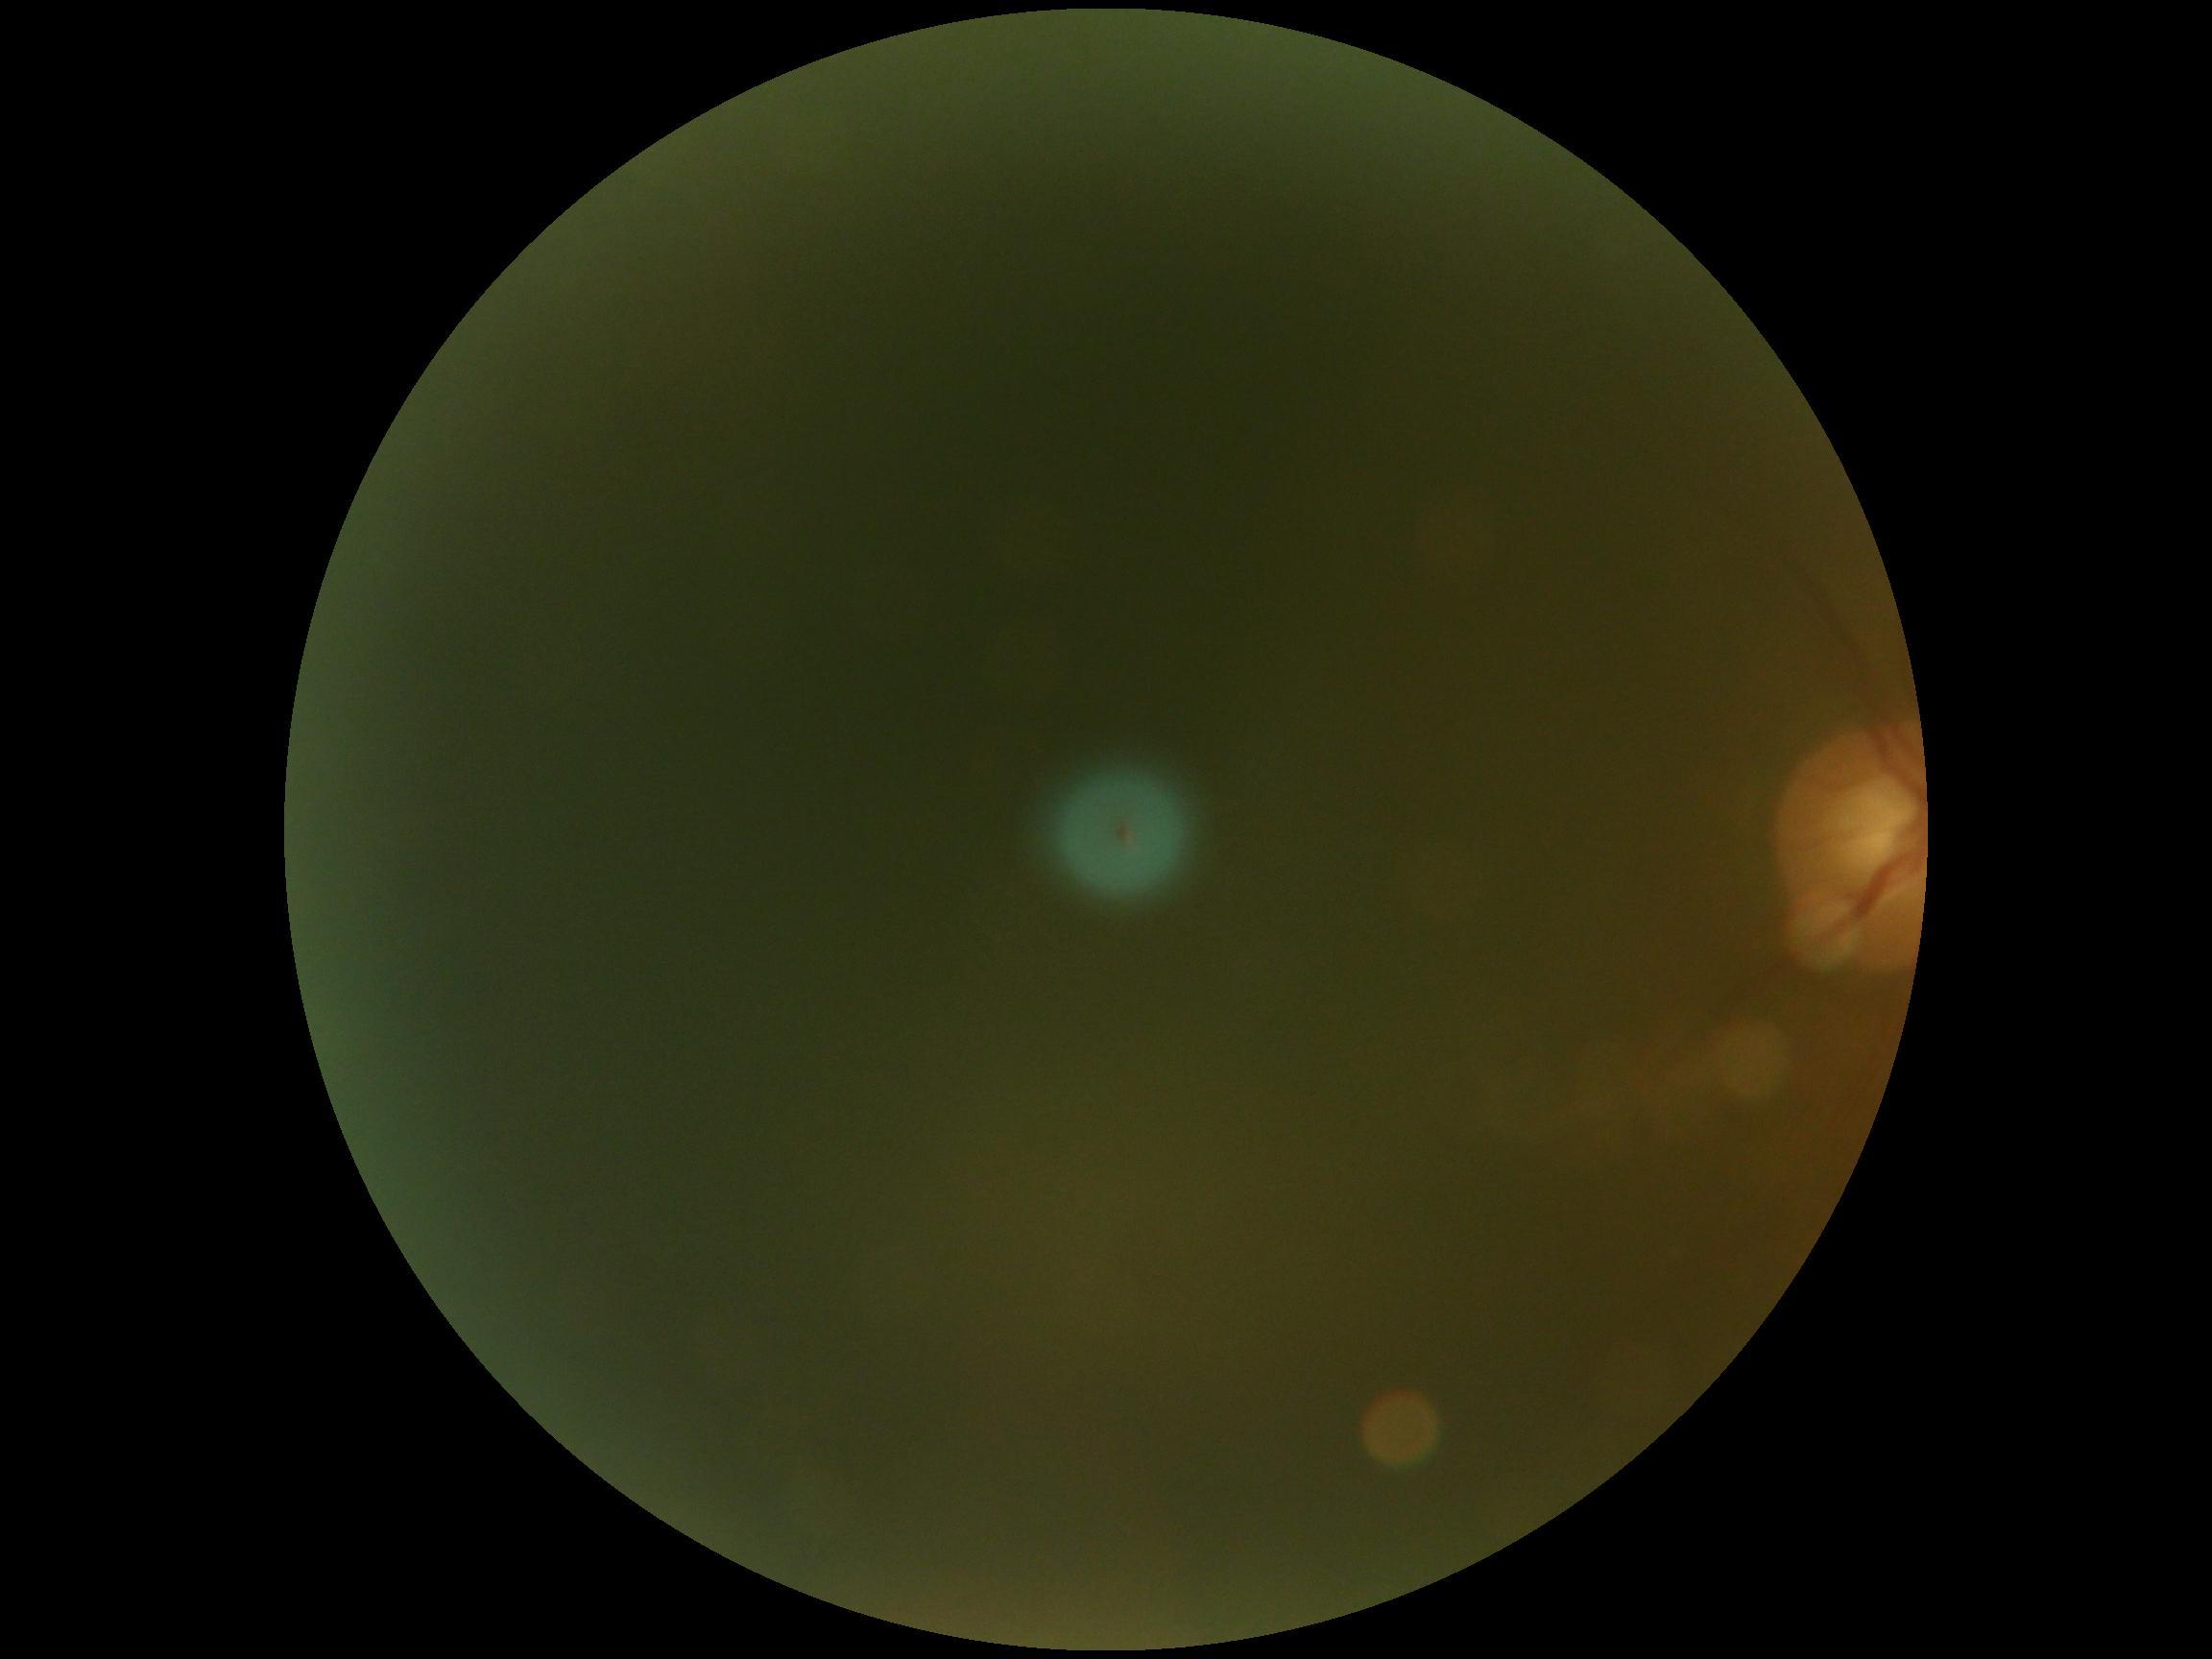   quality: below grading threshold
  dr_grade: ungradable